Acquired on the Phoenix ICON · pediatric retinal photograph (wide-field).
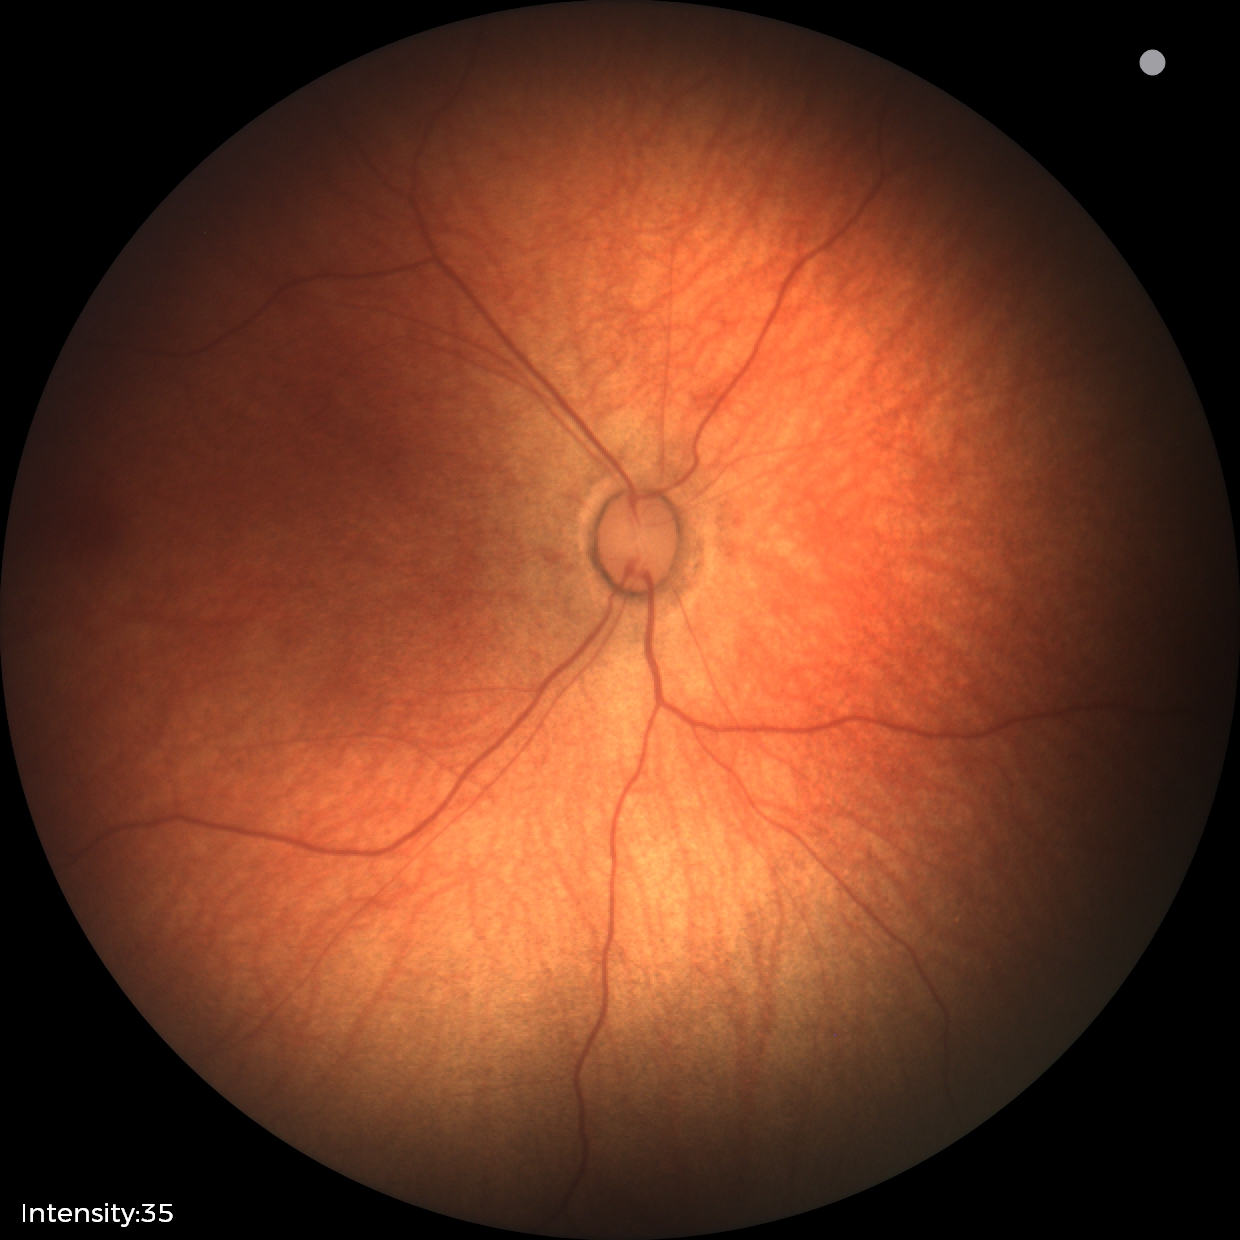
No retinal pathology identified on screening.